Wide-field fundus image from infant ROP screening: 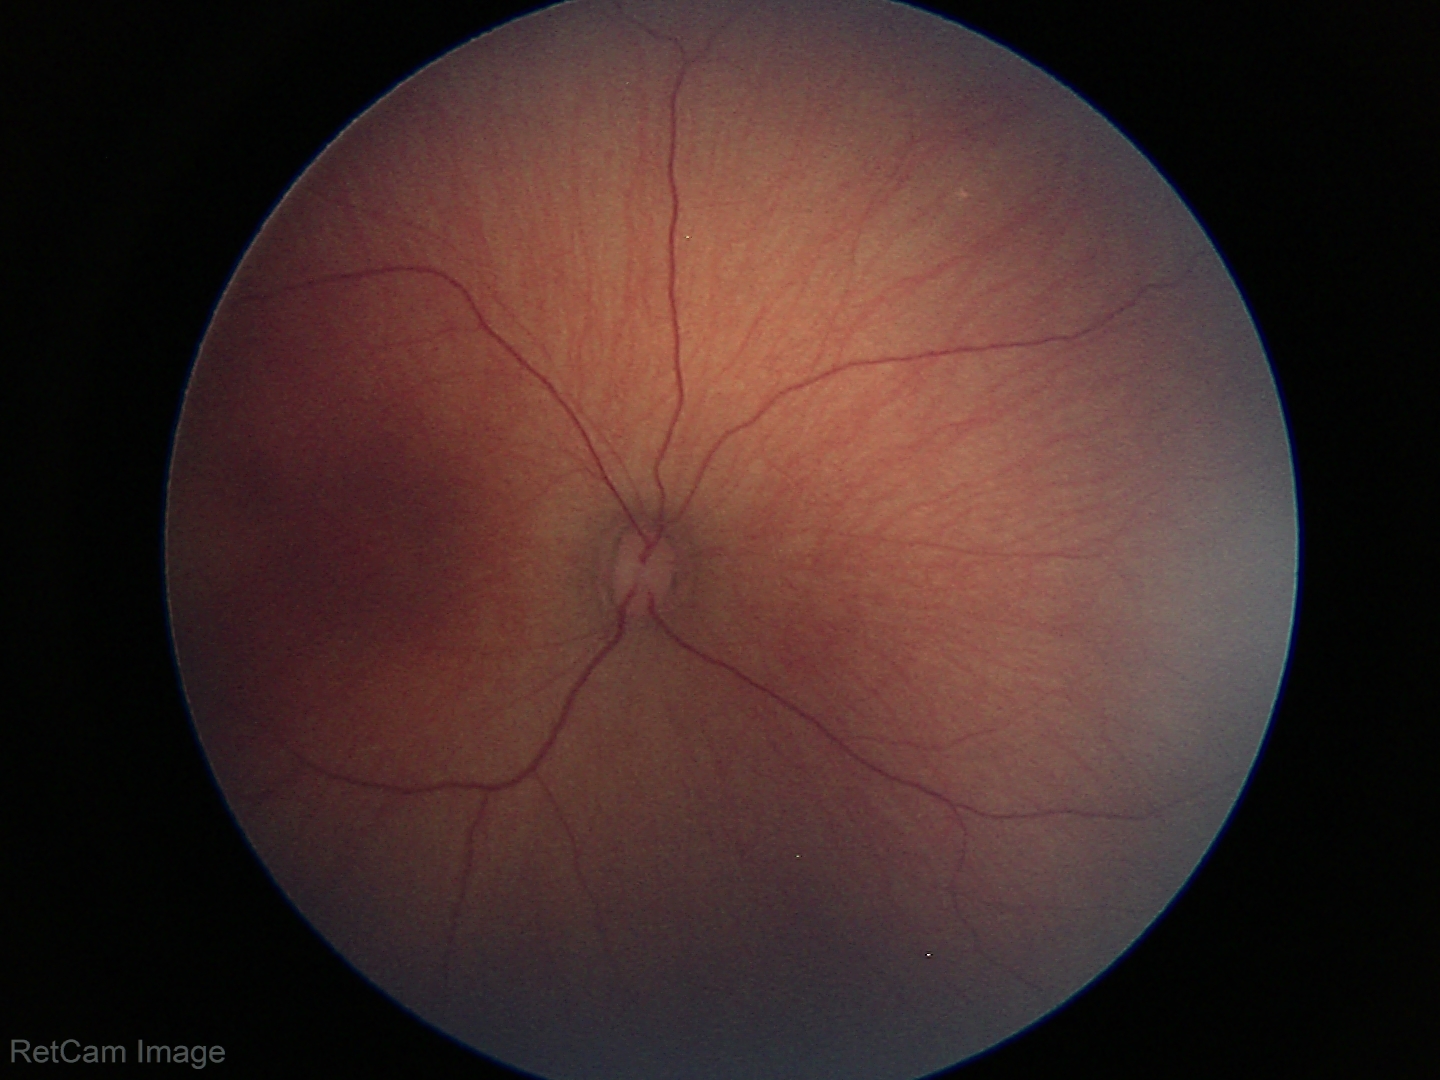

Normal screening examination.